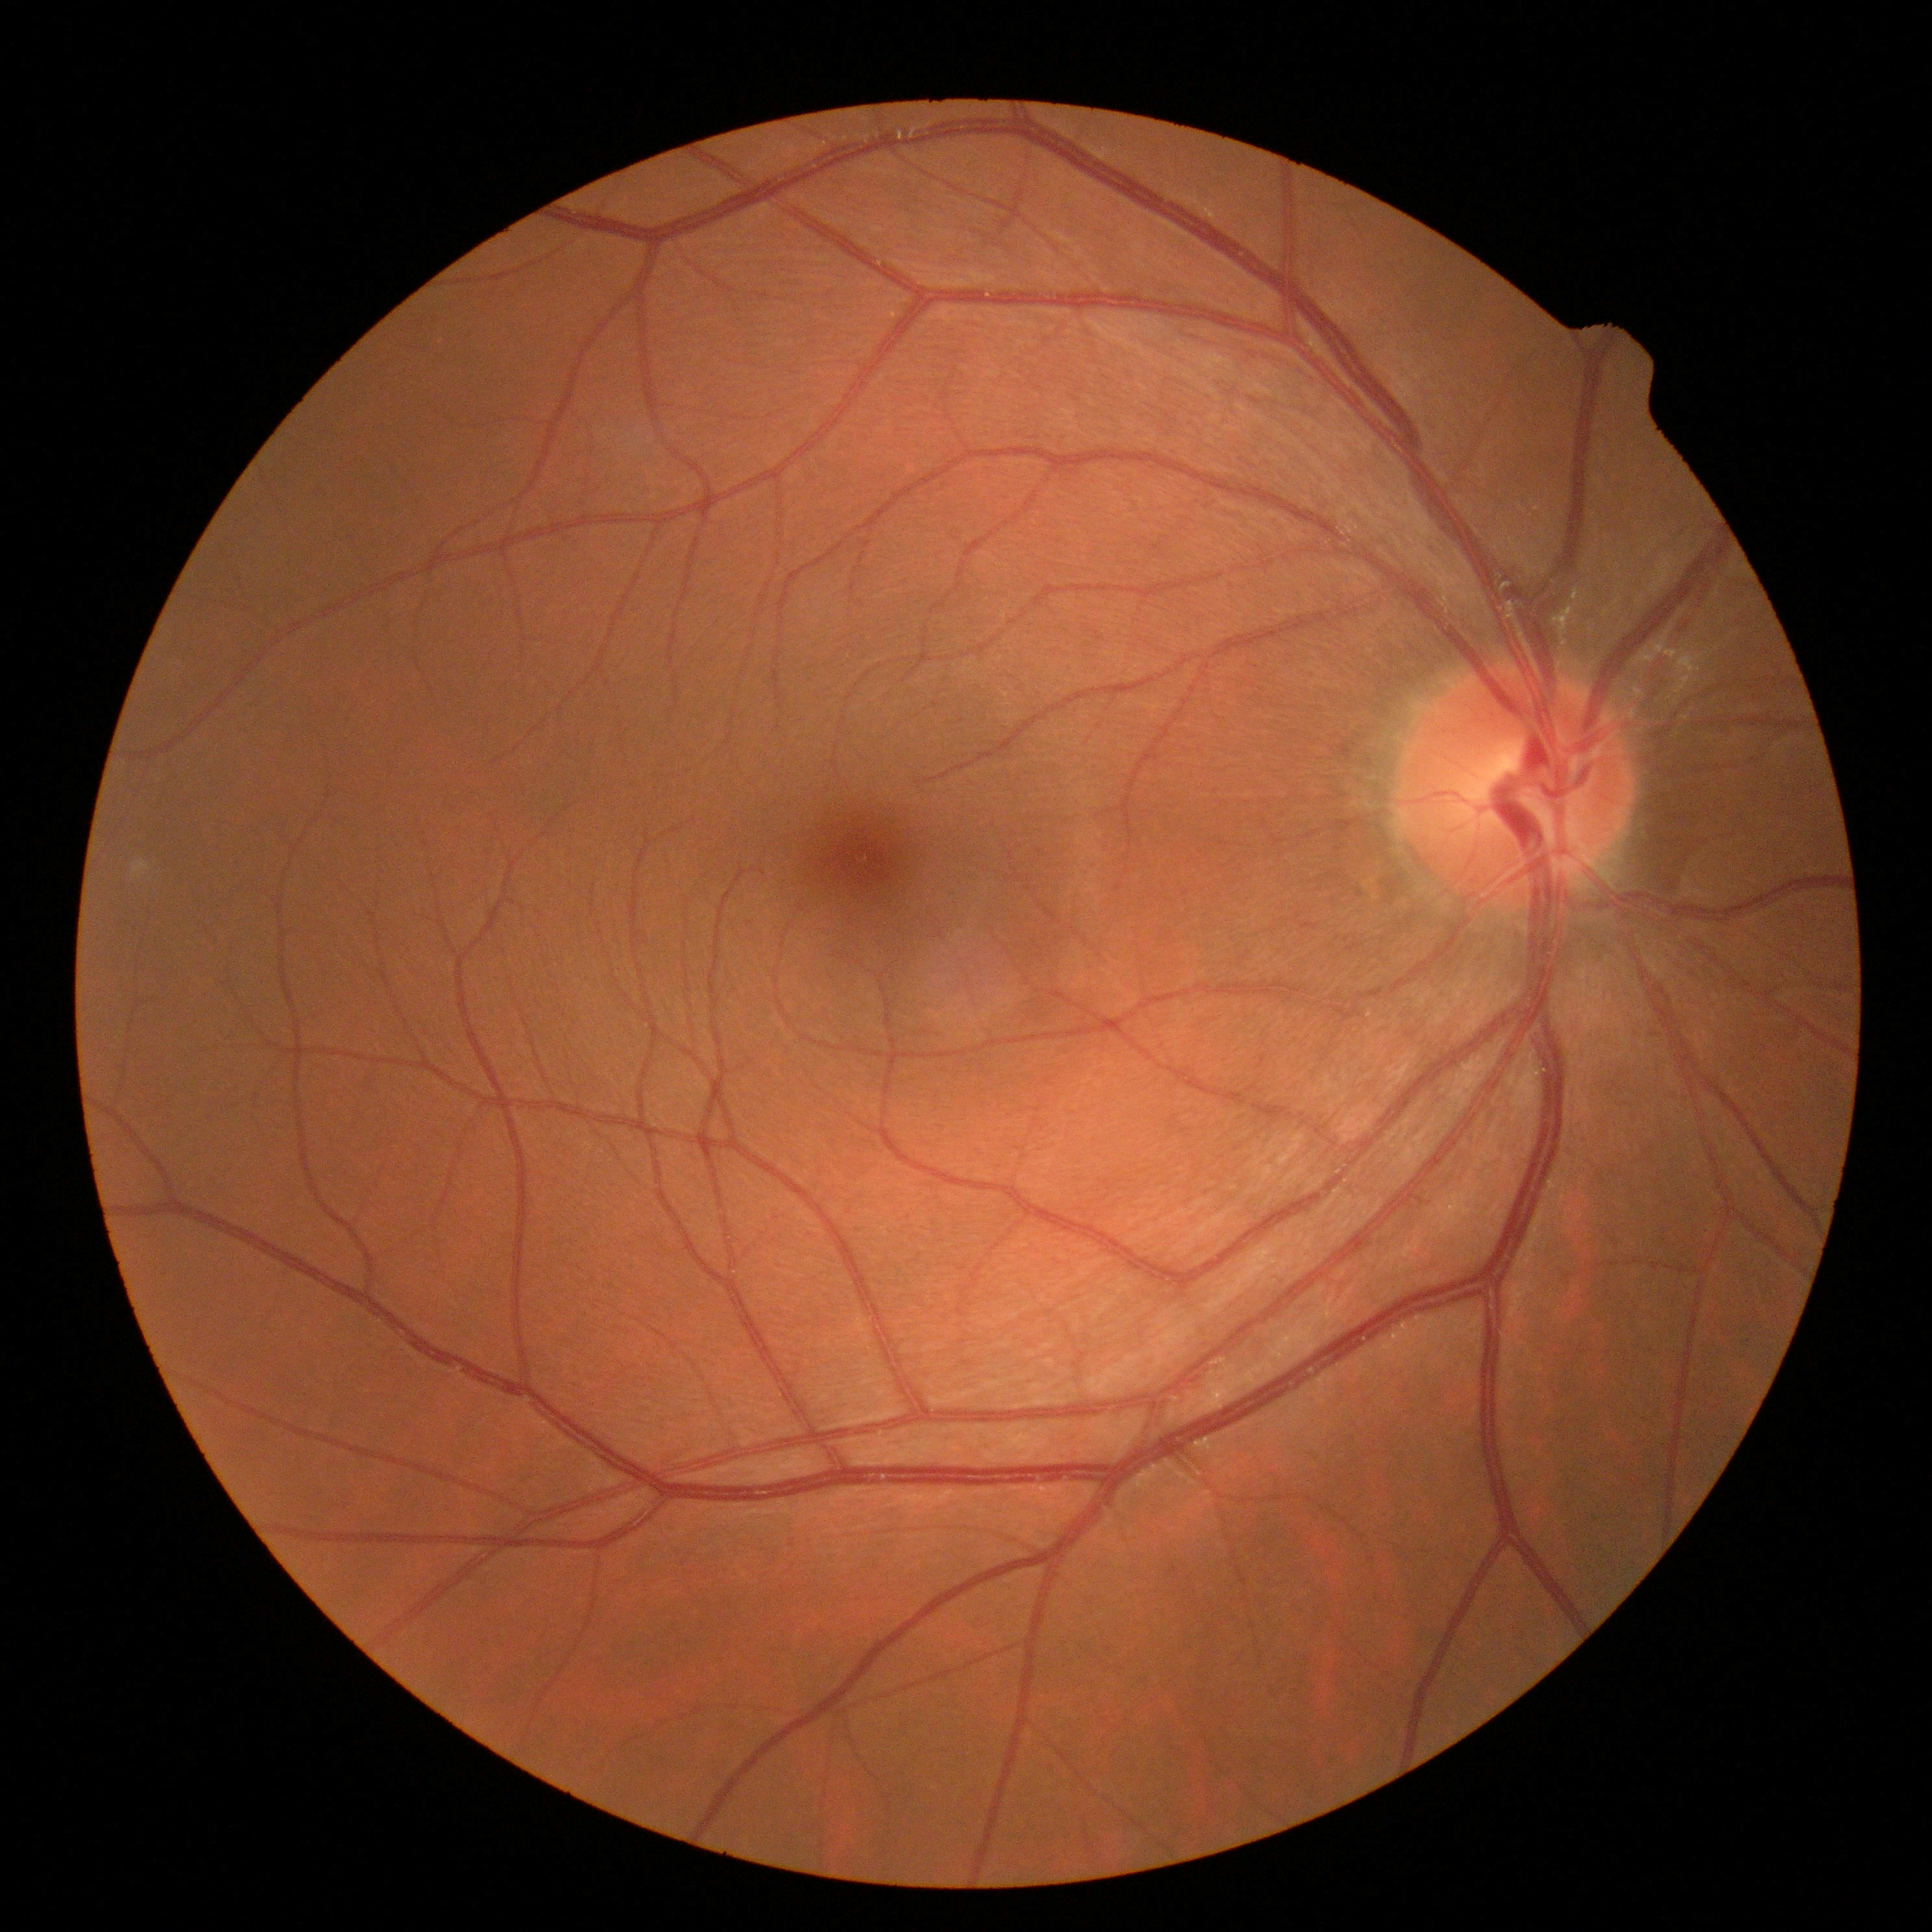
diabetic retinopathy=0.